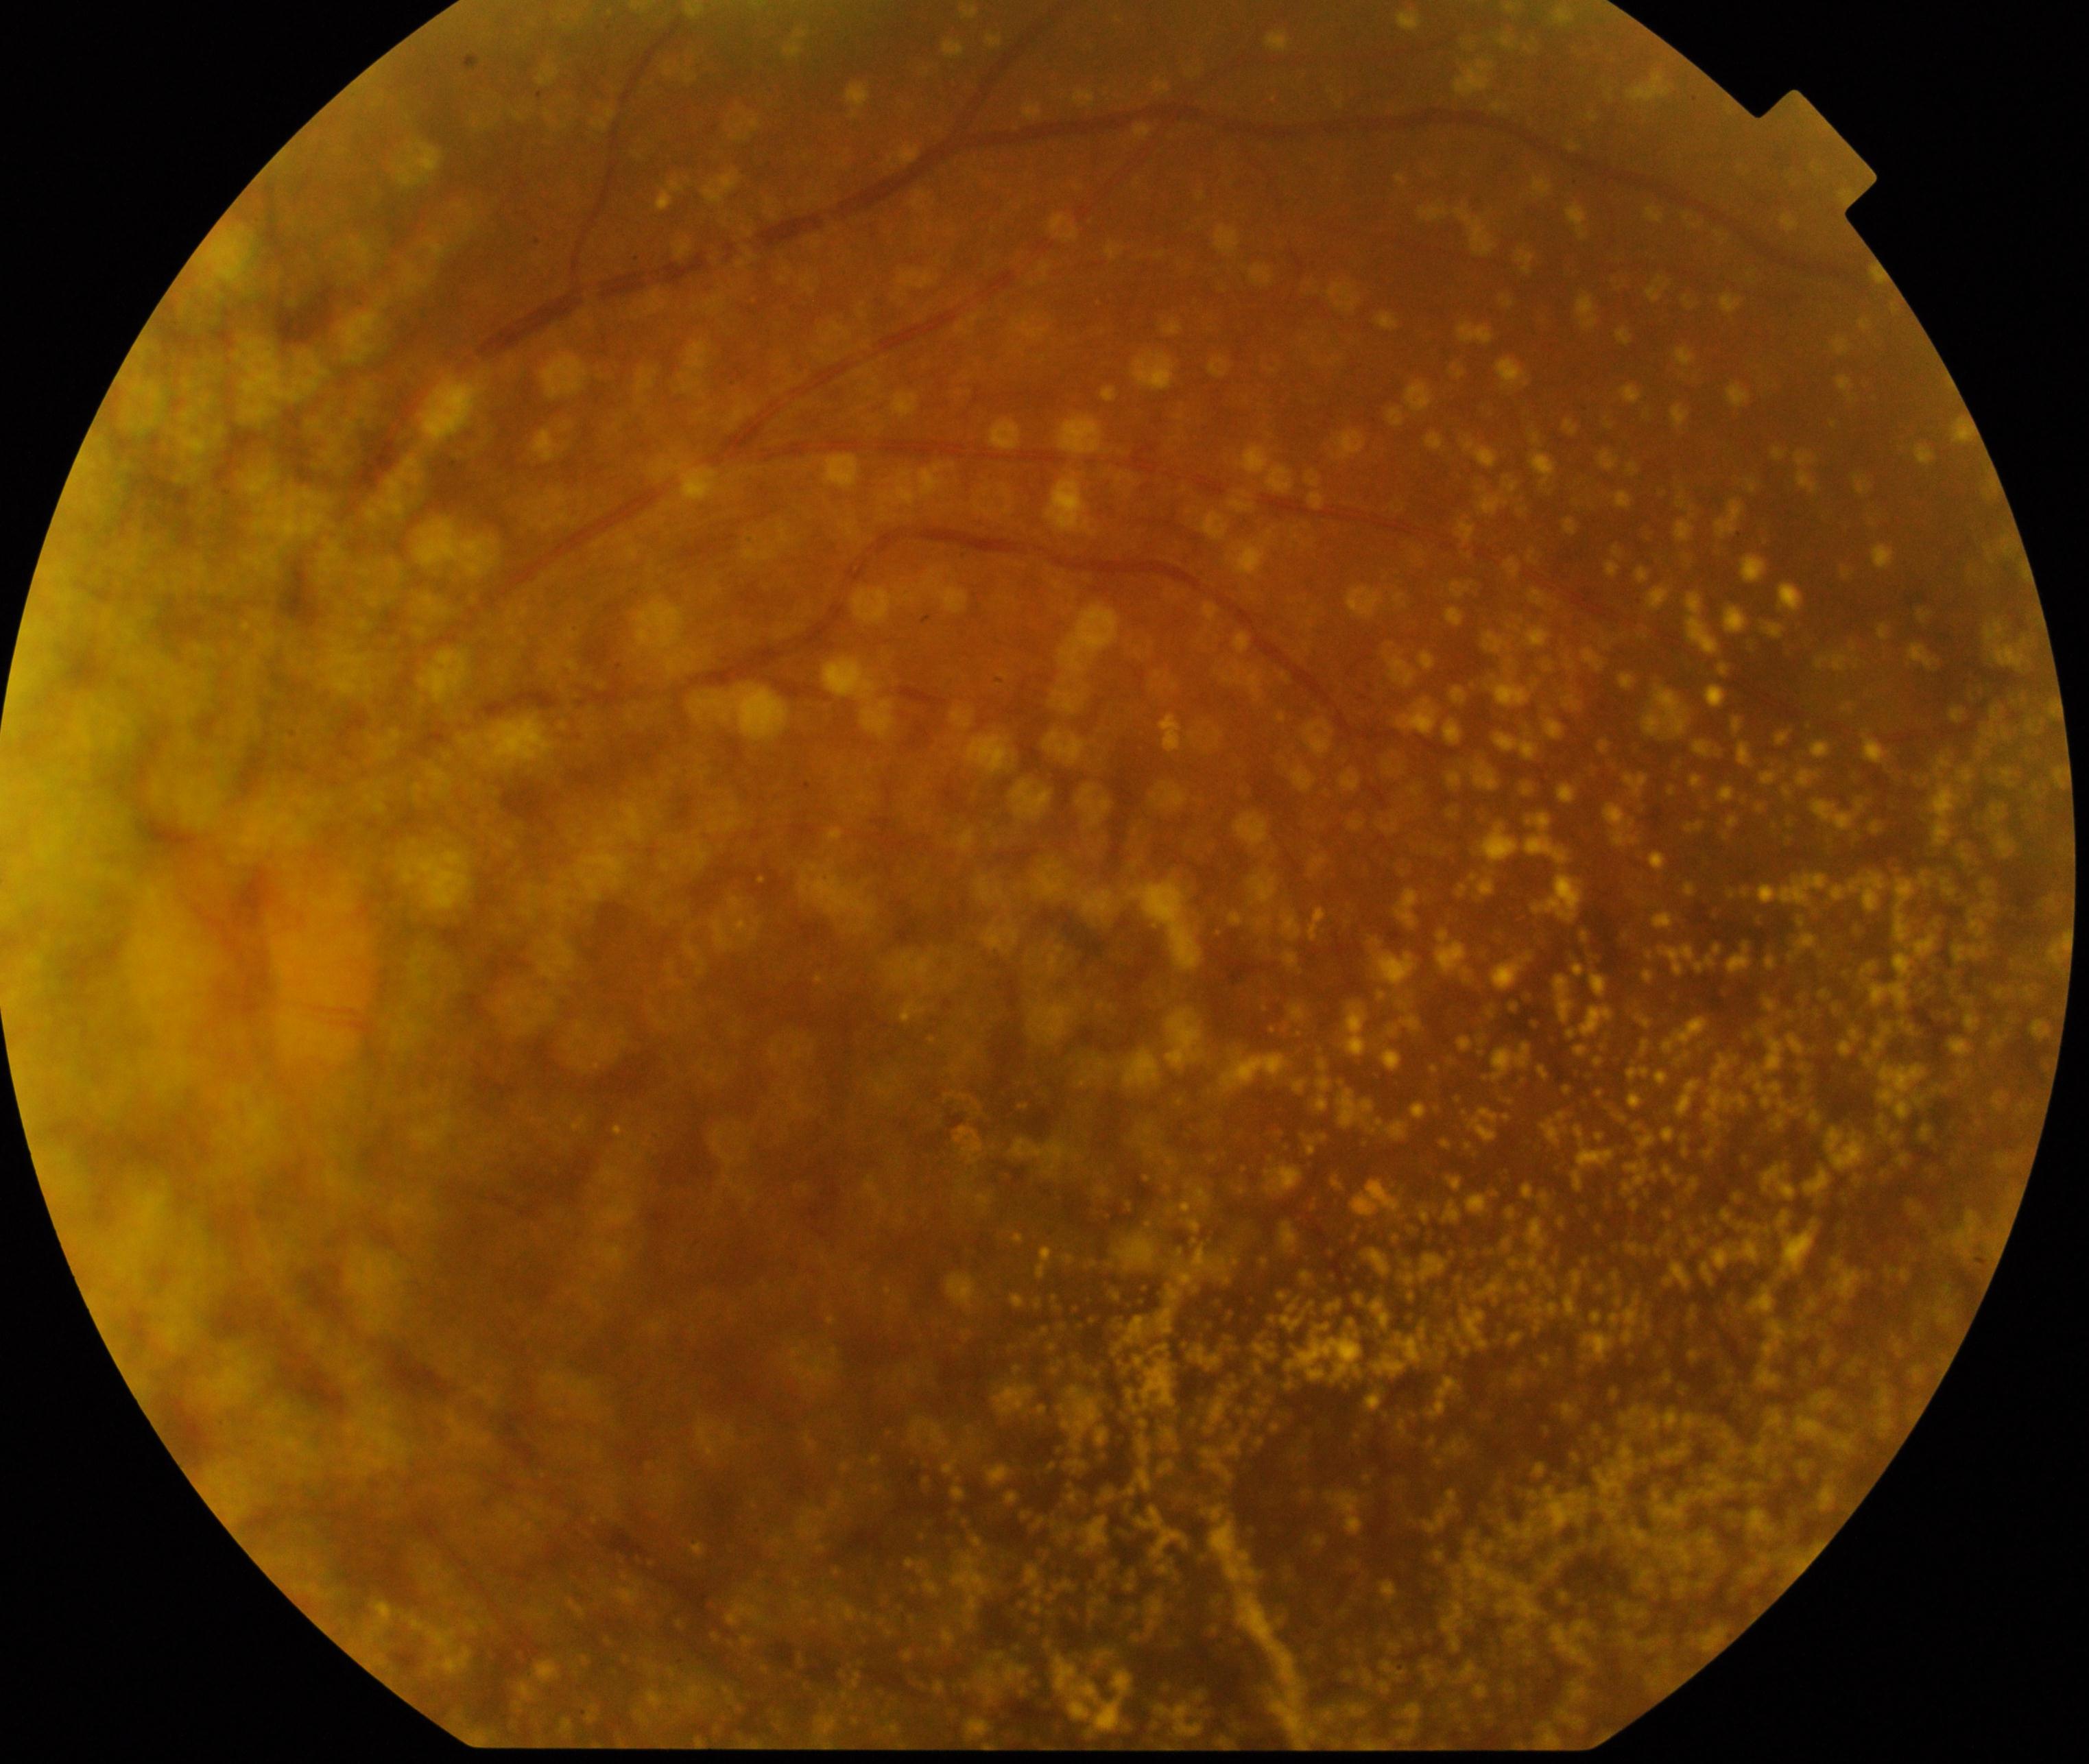 There is evidence of vitreous particles. Typically showing vitreous opacities including asteroid hyalosis, synchysis scintillans, and deposits of familial amyloidosis.